45-degree field of view — 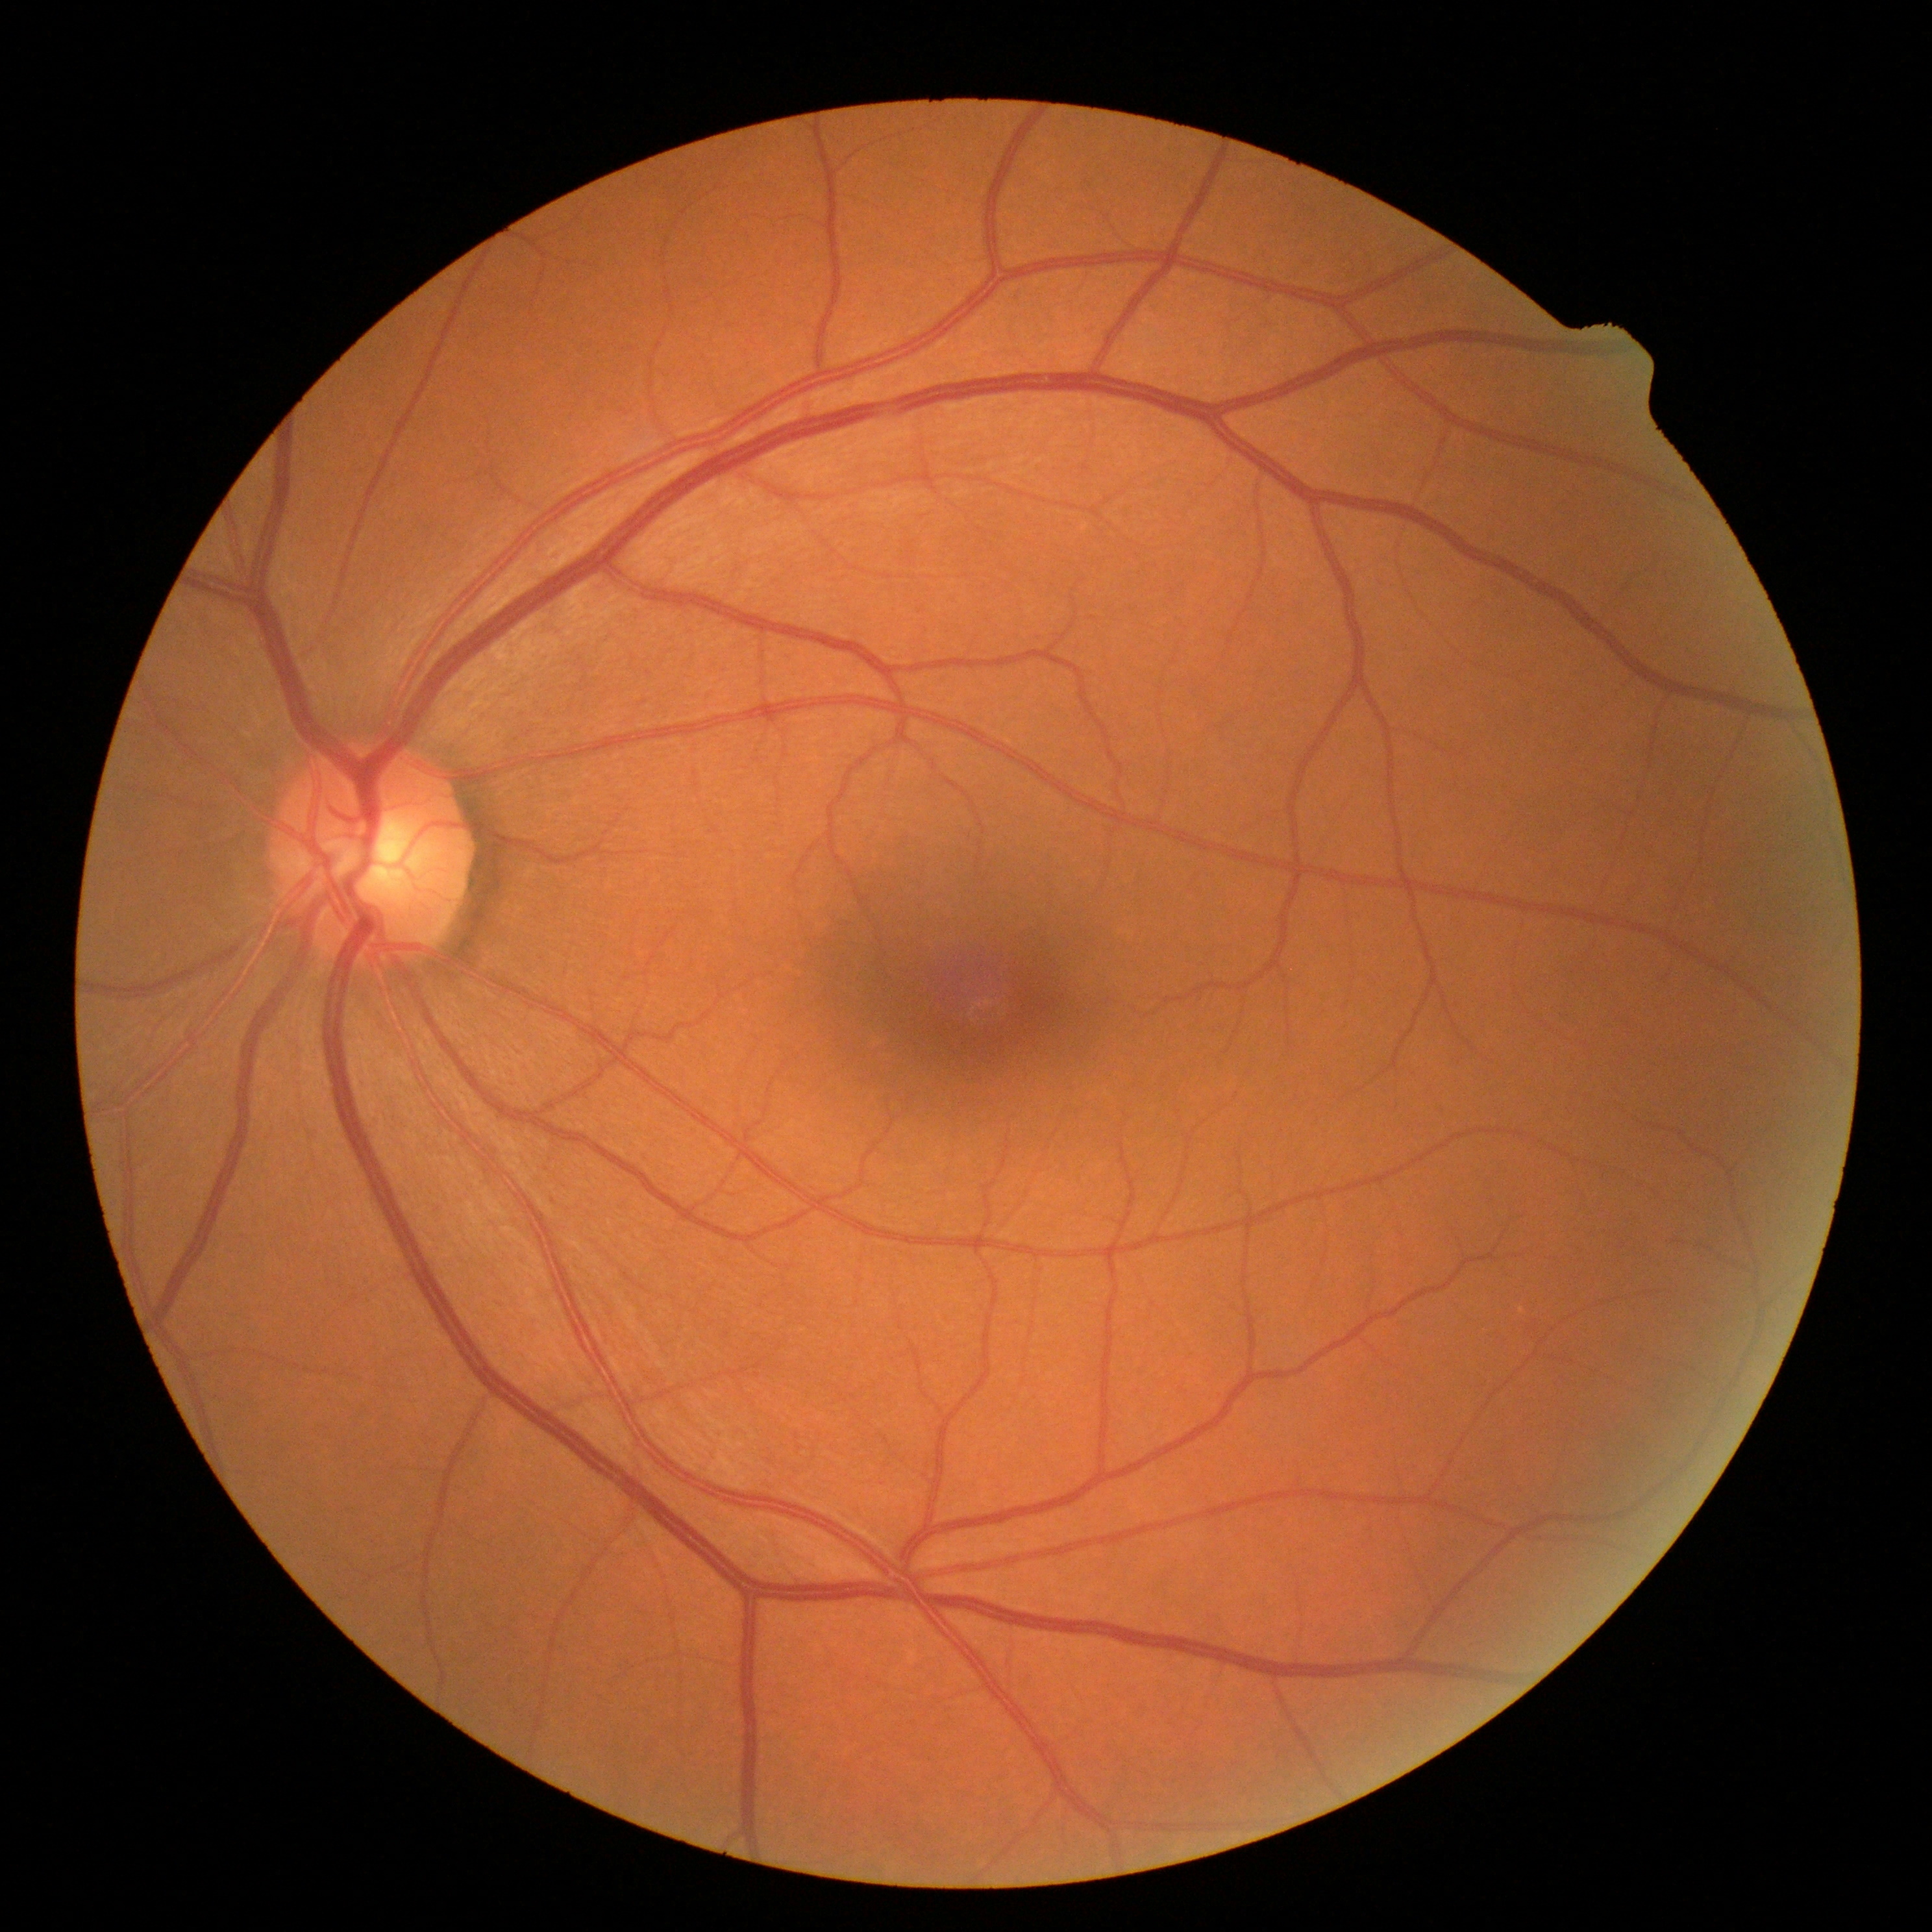 No DR findings. Diabetic retinopathy (DR) is no apparent retinopathy (grade 0).